Color fundus image:
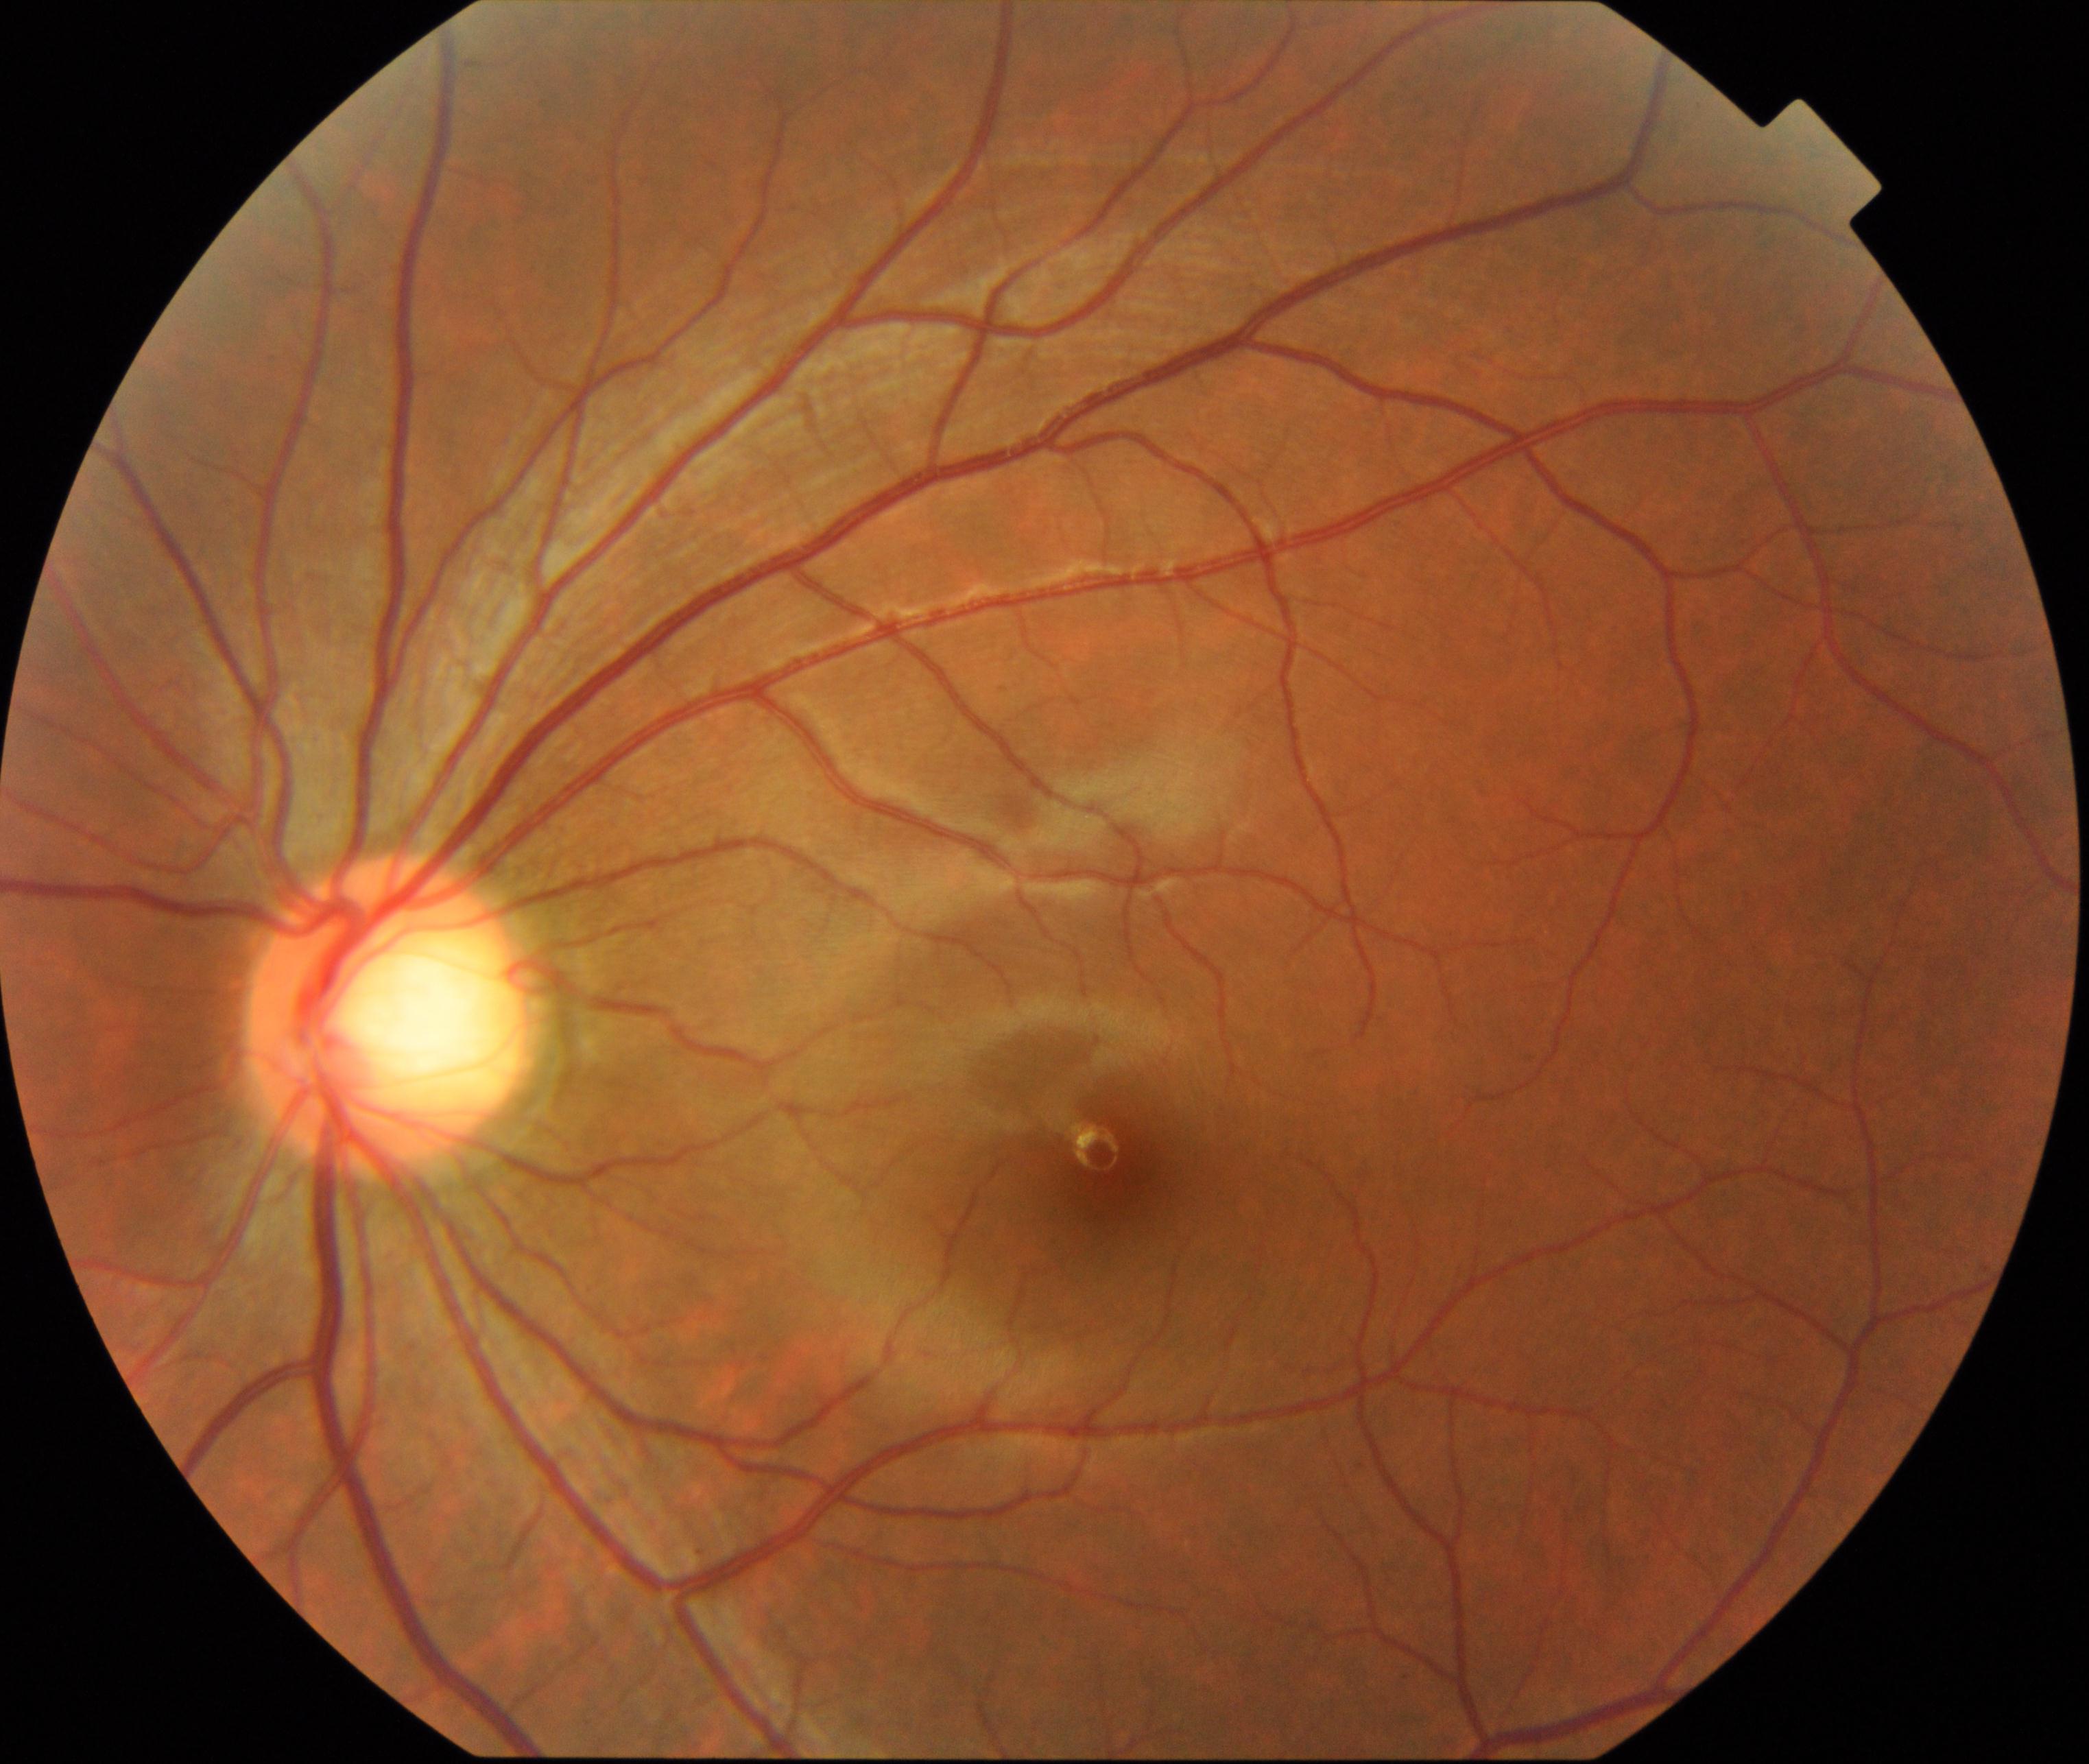

Diagnosis: large optic cup. Characterized by cup-to-disc ratio greater than 0.5, with a pink neuroretinal rim following the ISNT rule, without notching or bayoneting of vessels.